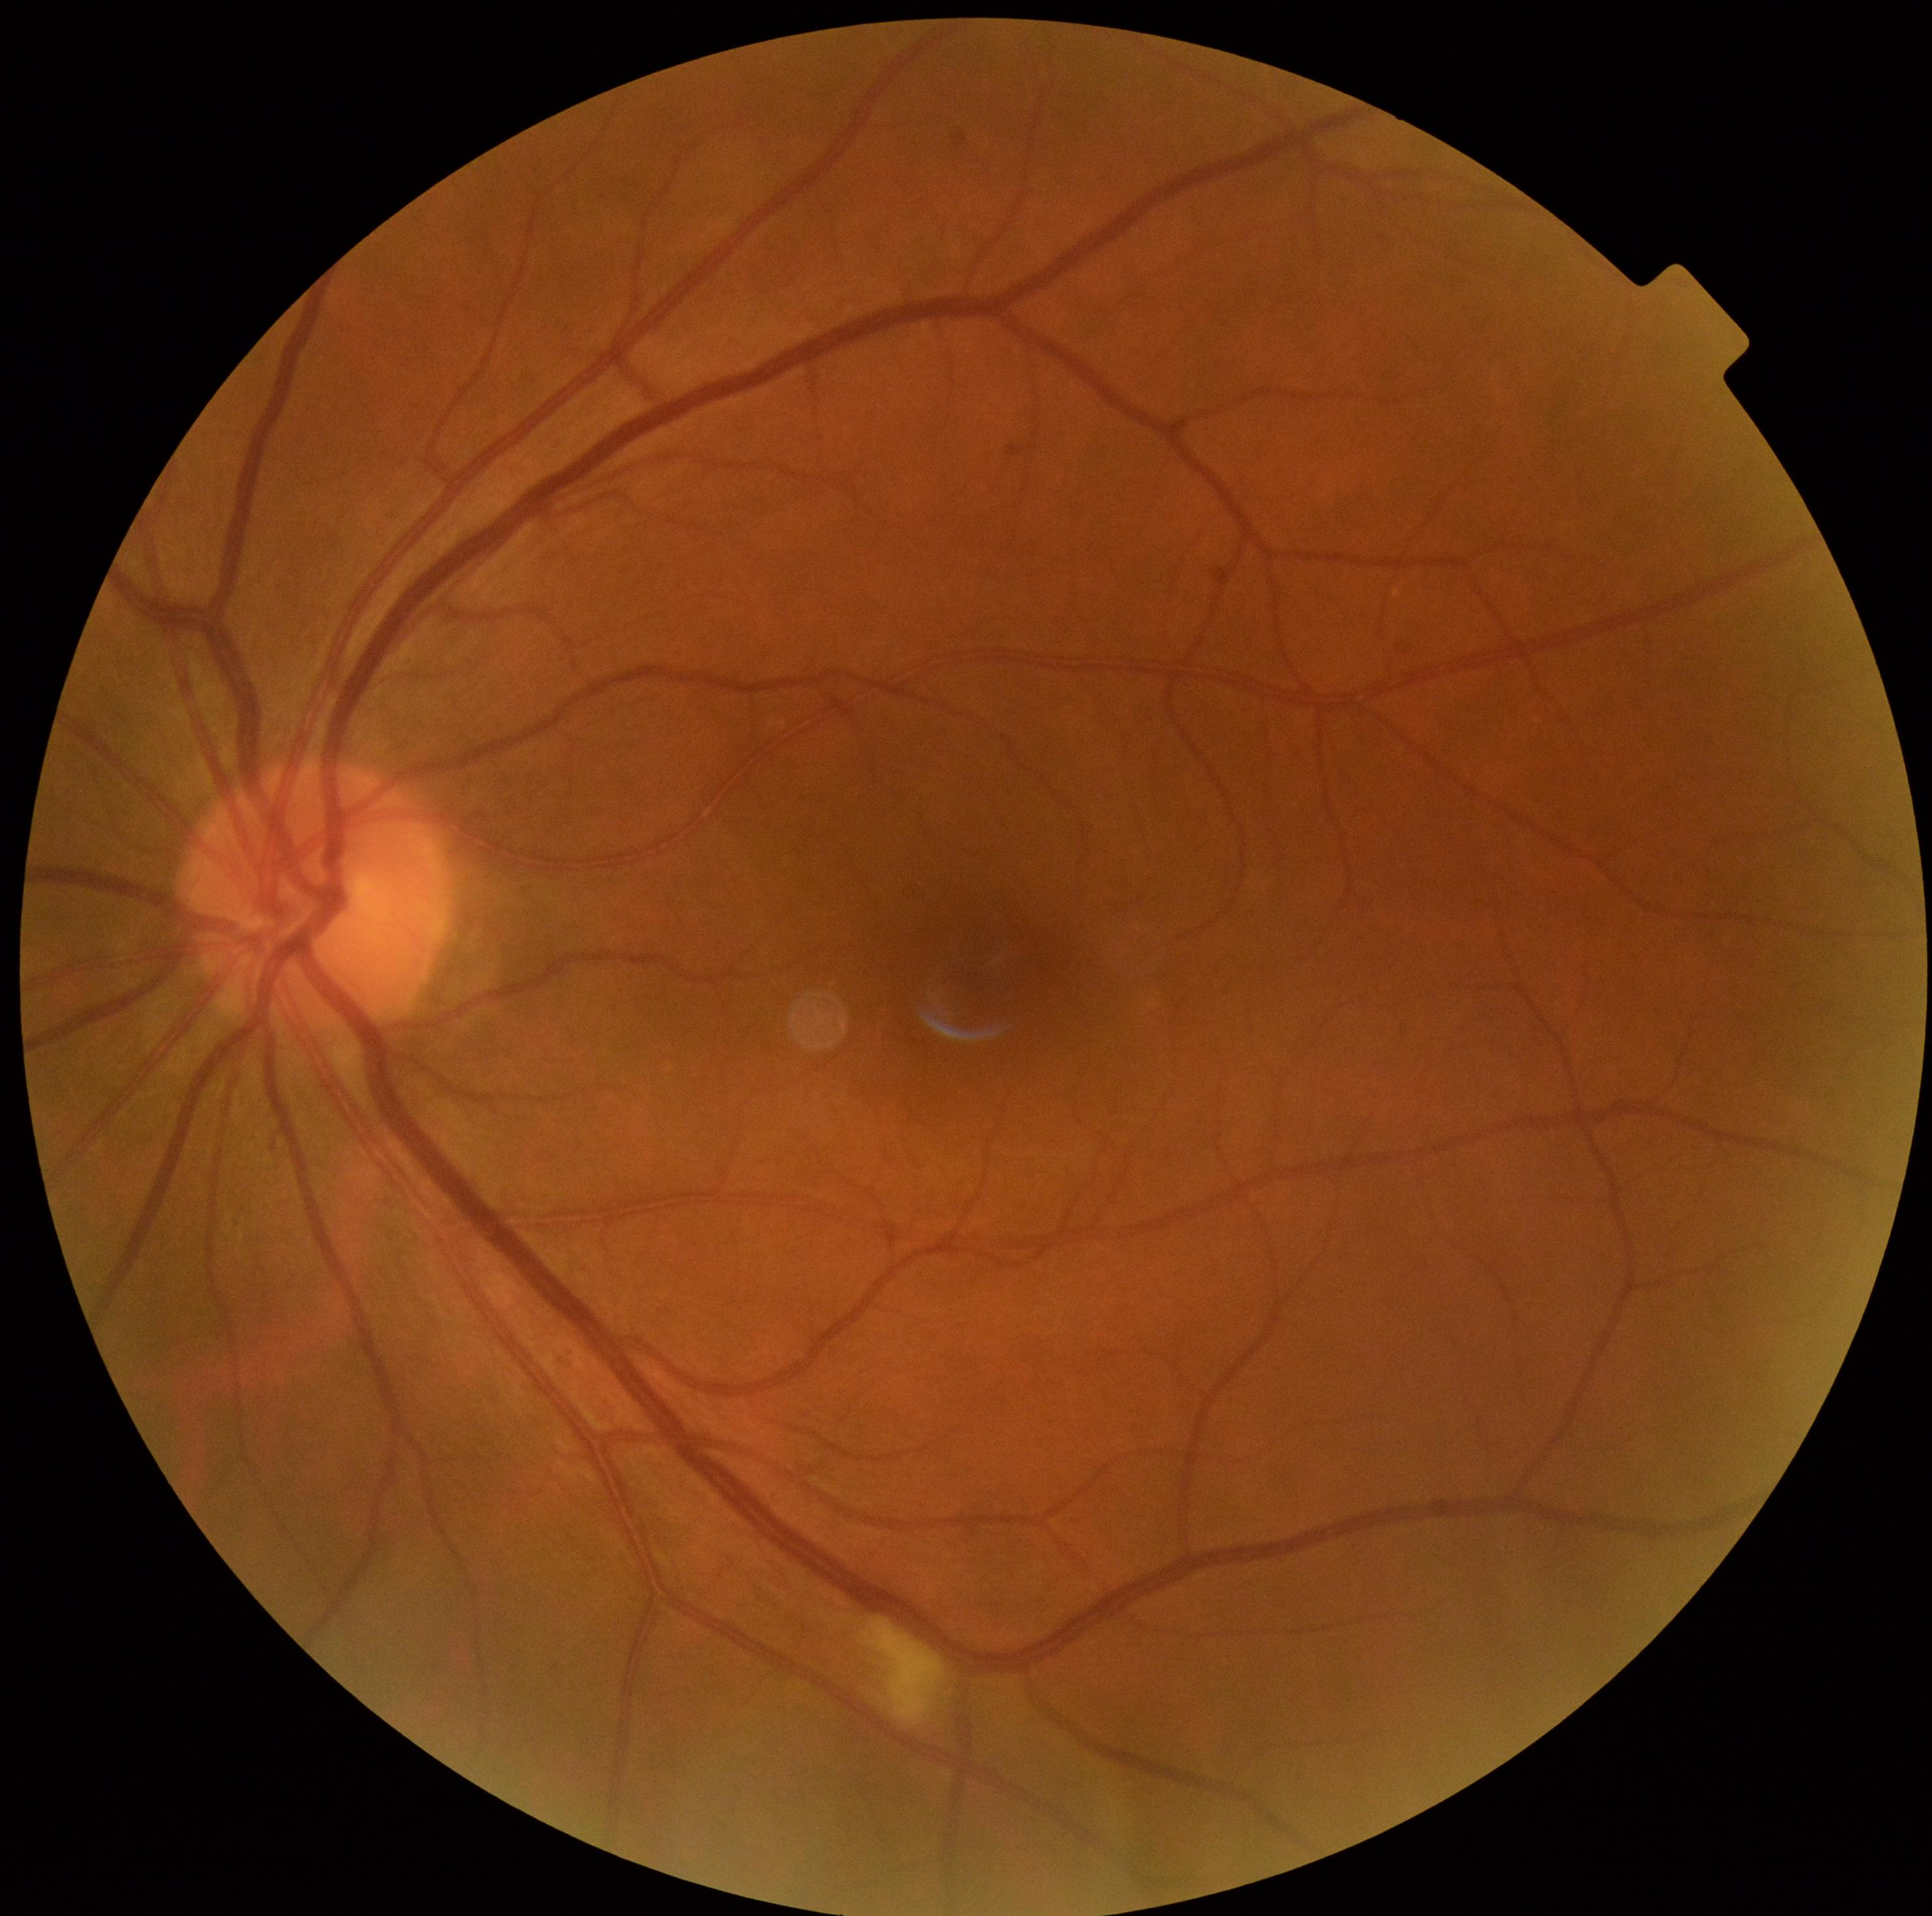
DR class: non-proliferative diabetic retinopathy.
DR severity is grade 2 (moderate NPDR).